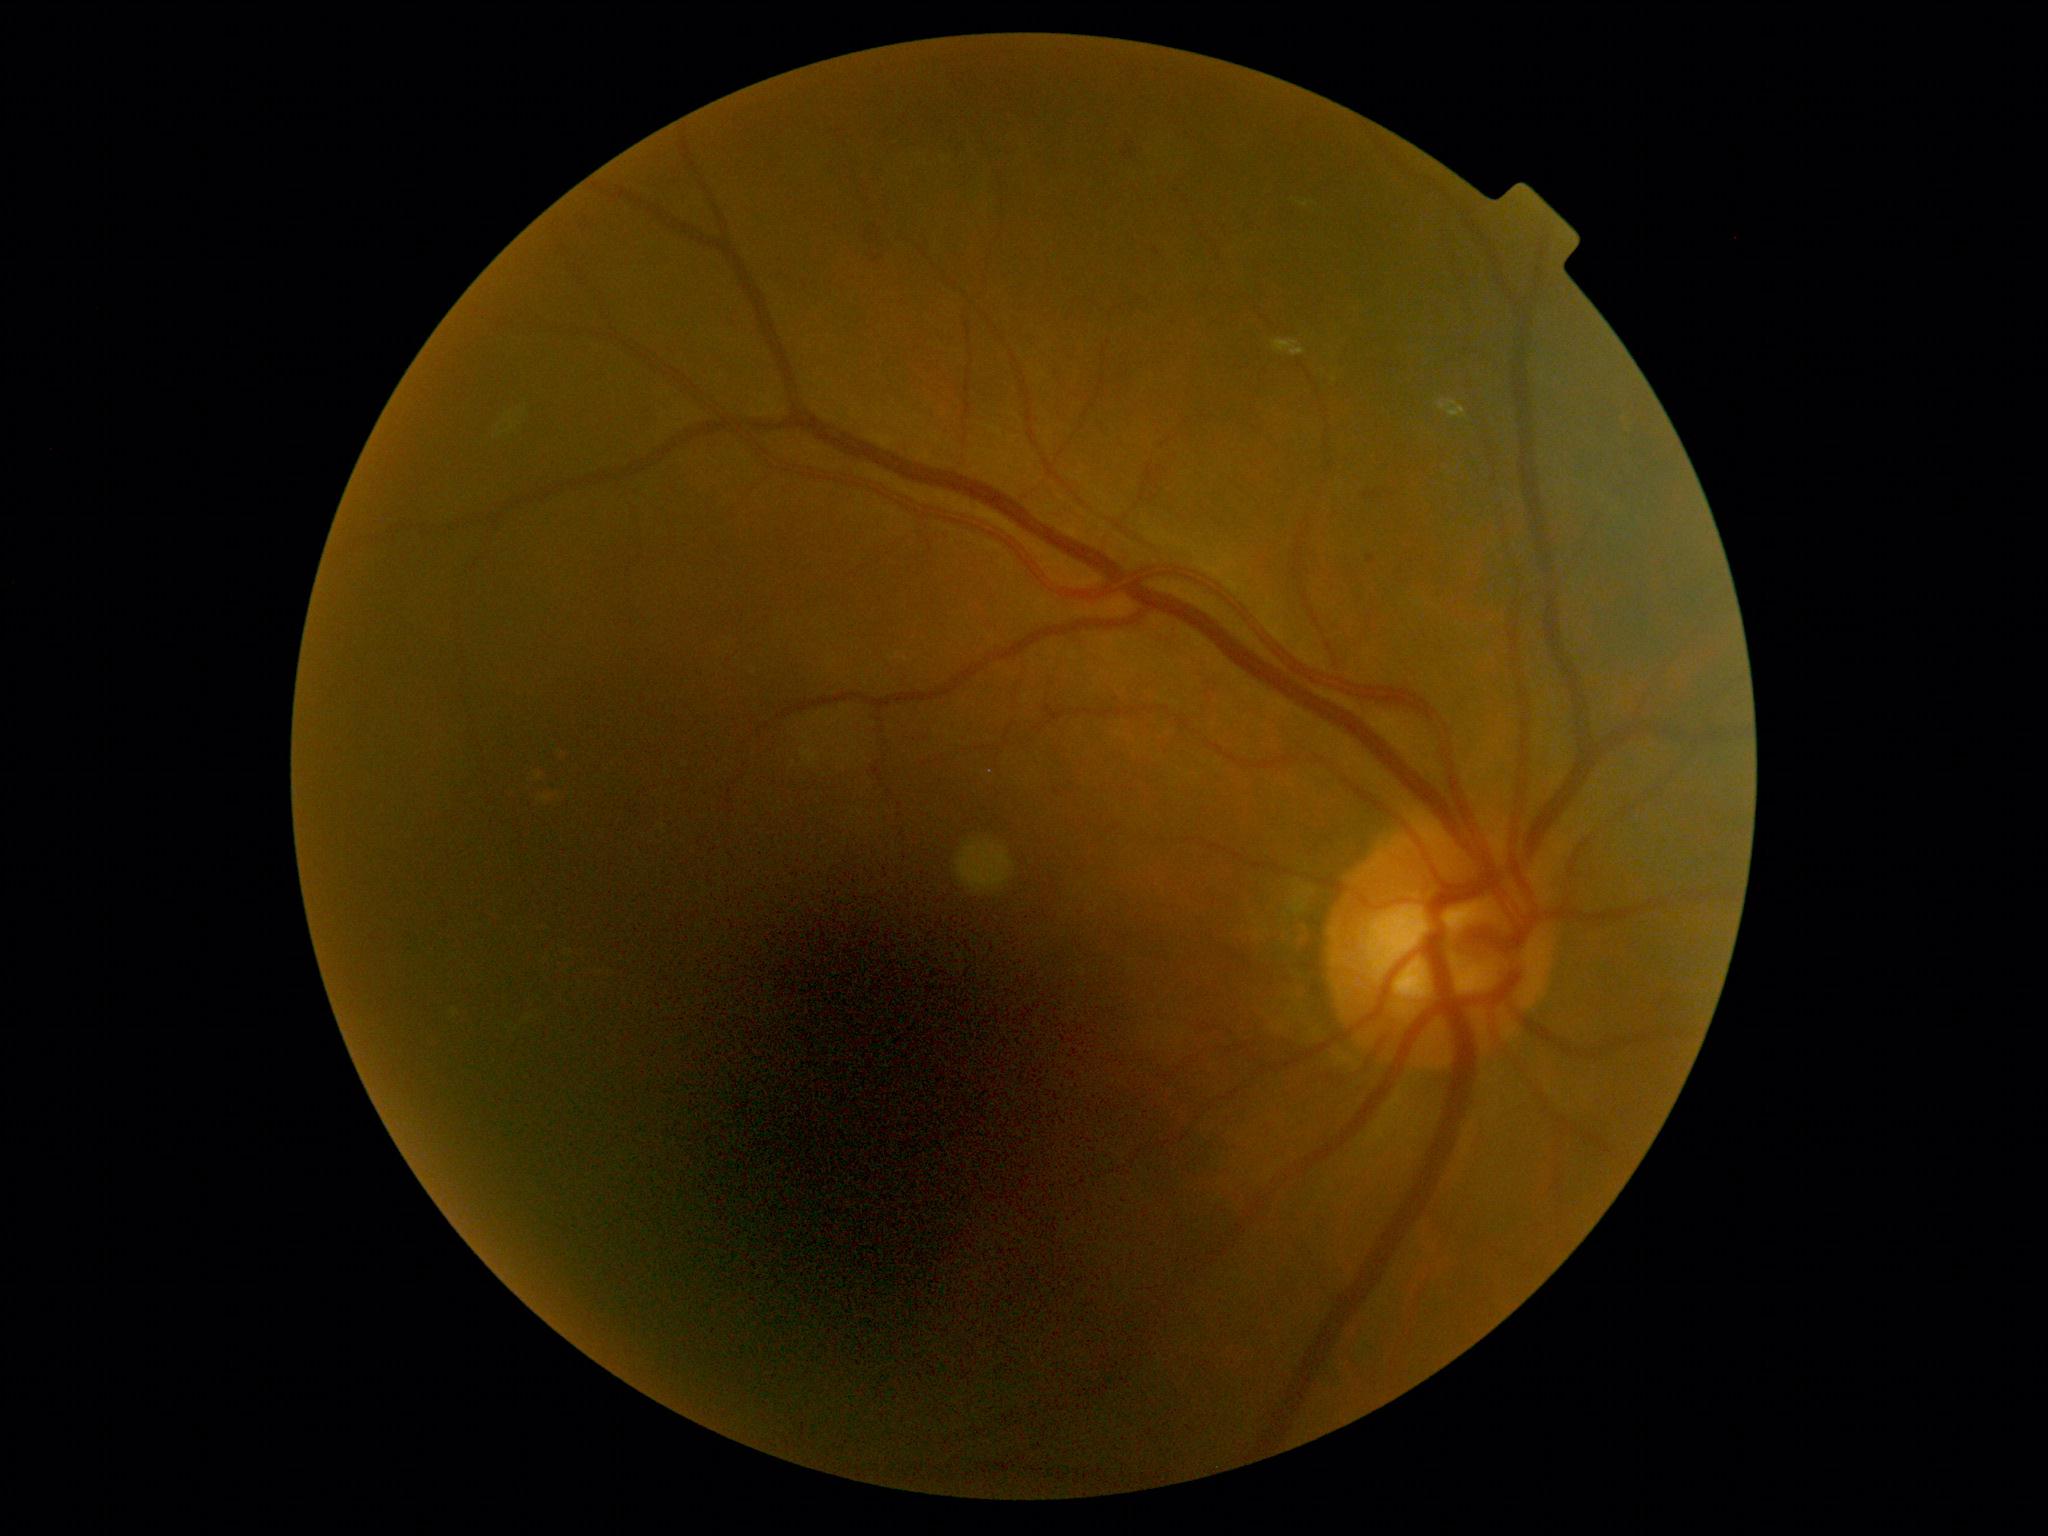 DR class: non-proliferative diabetic retinopathy. DR: grade 2 (moderate NPDR).